Color fundus photograph:
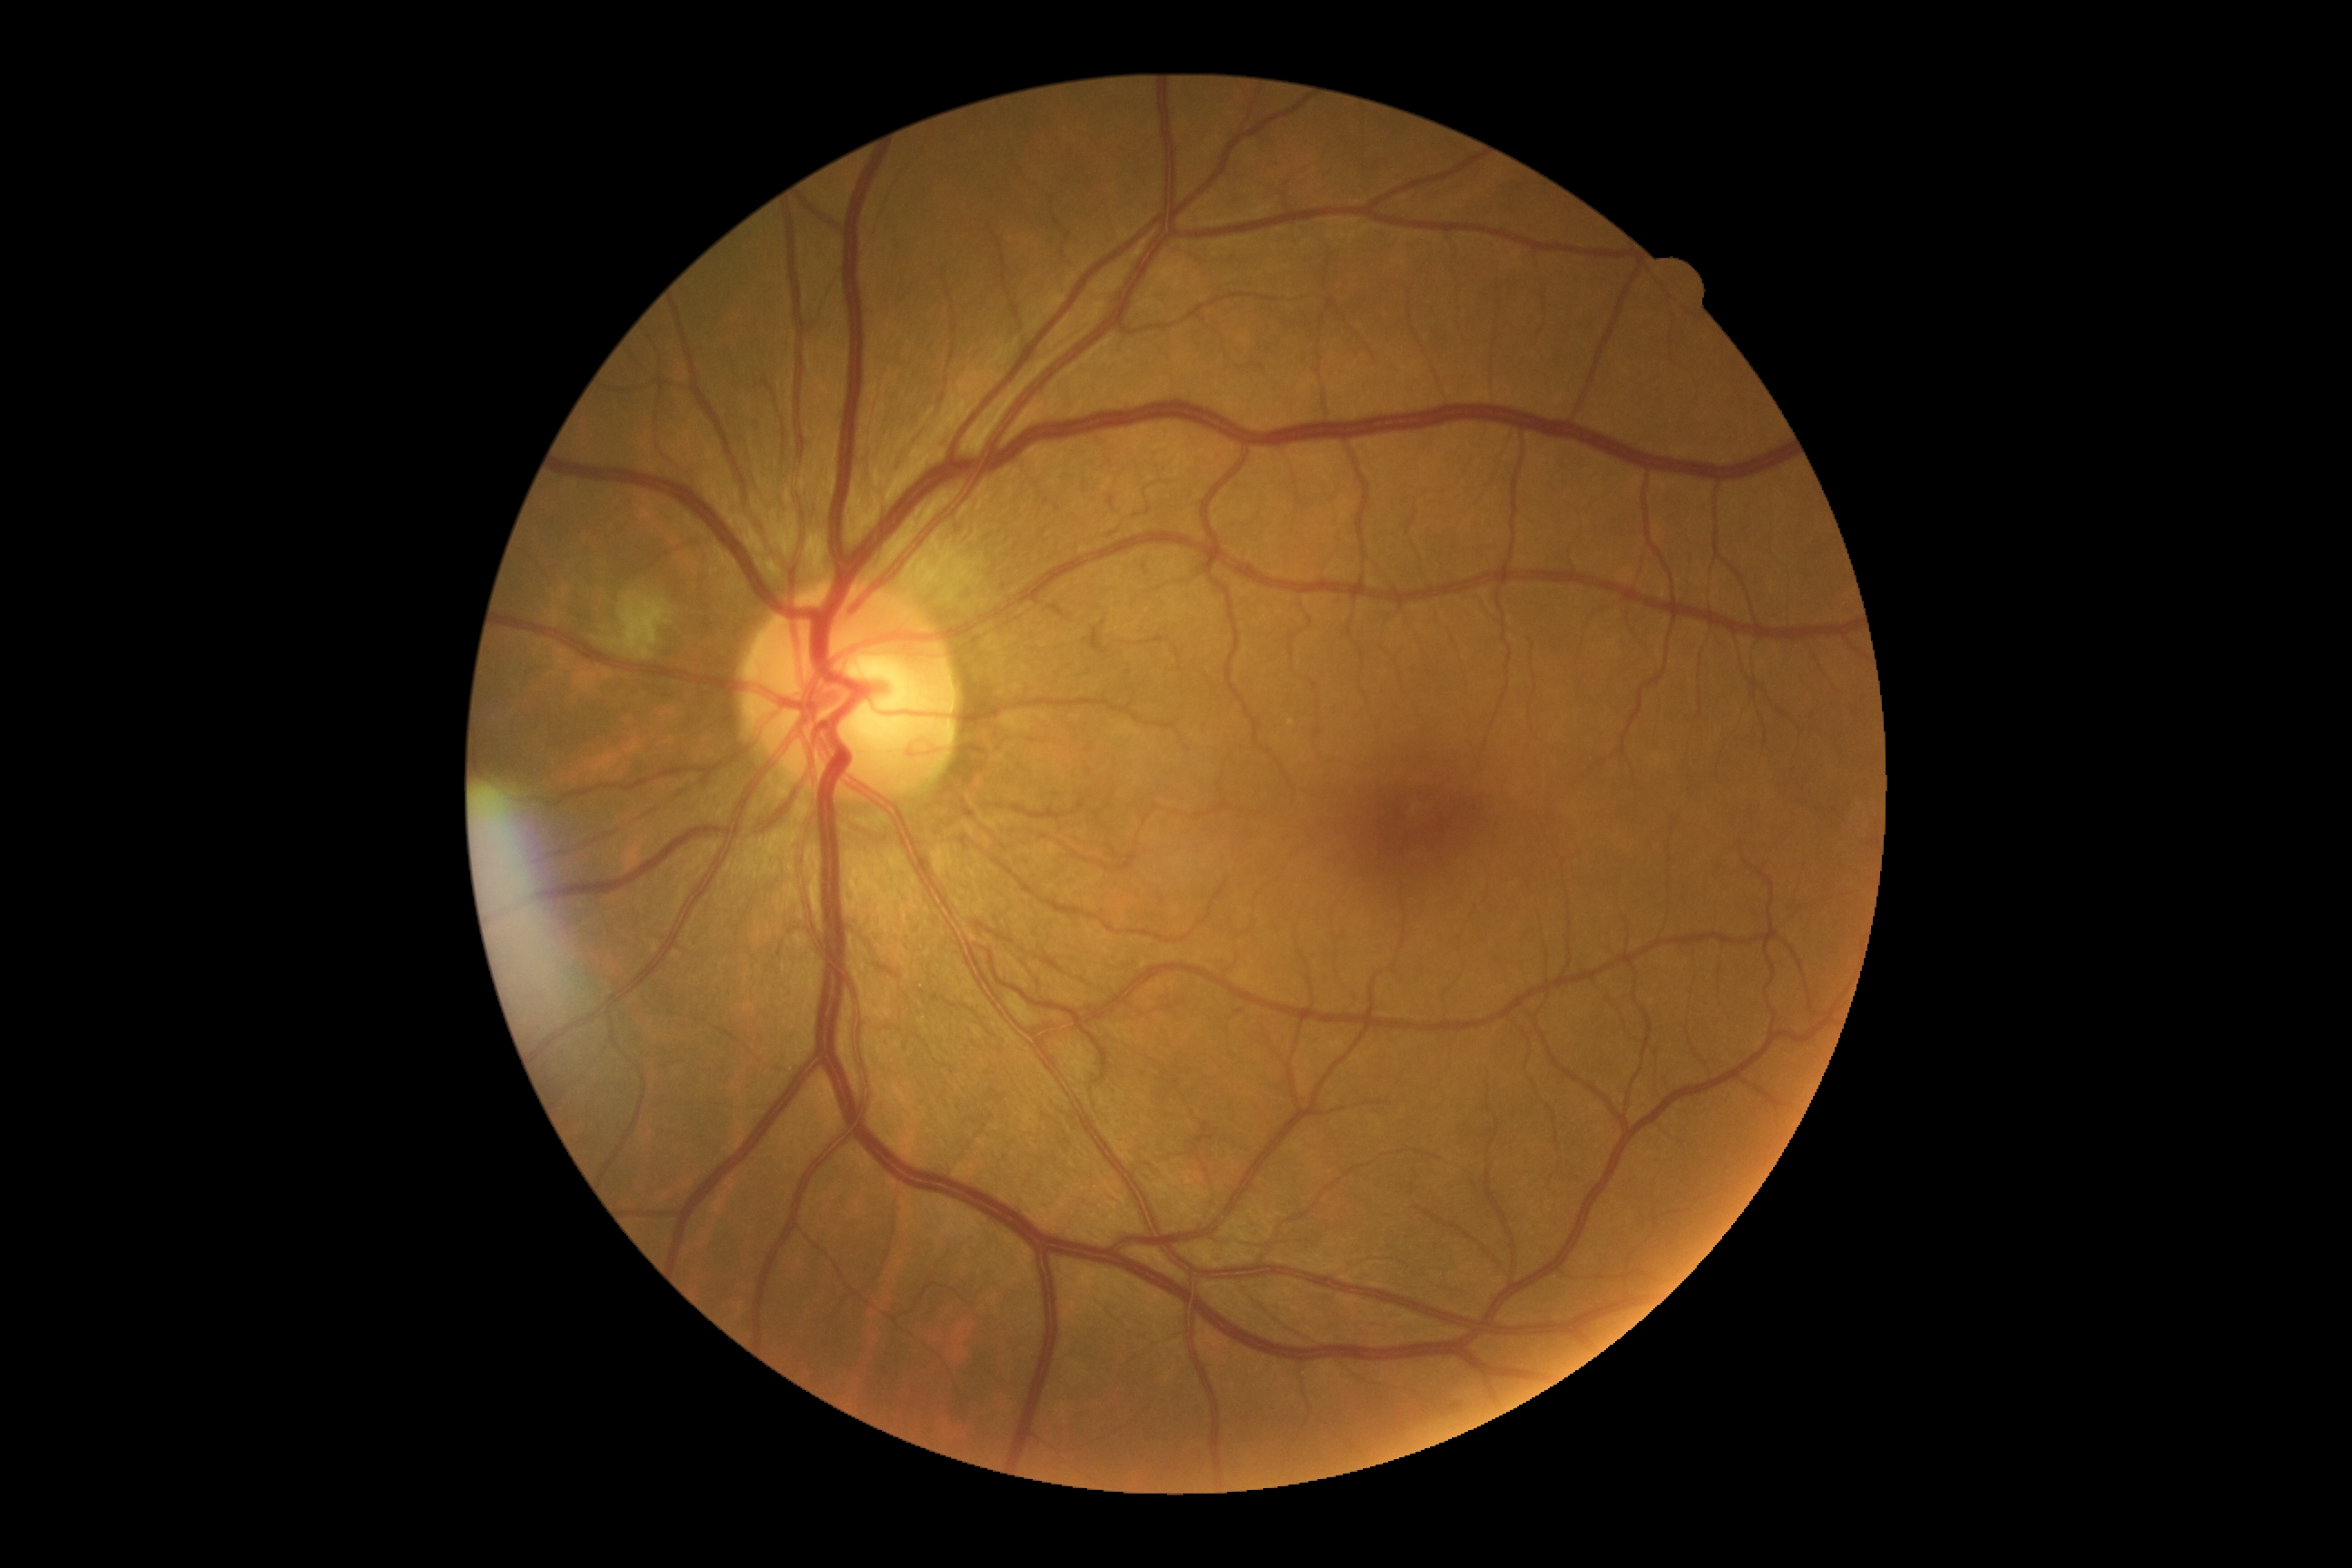
  dr_grade: 2